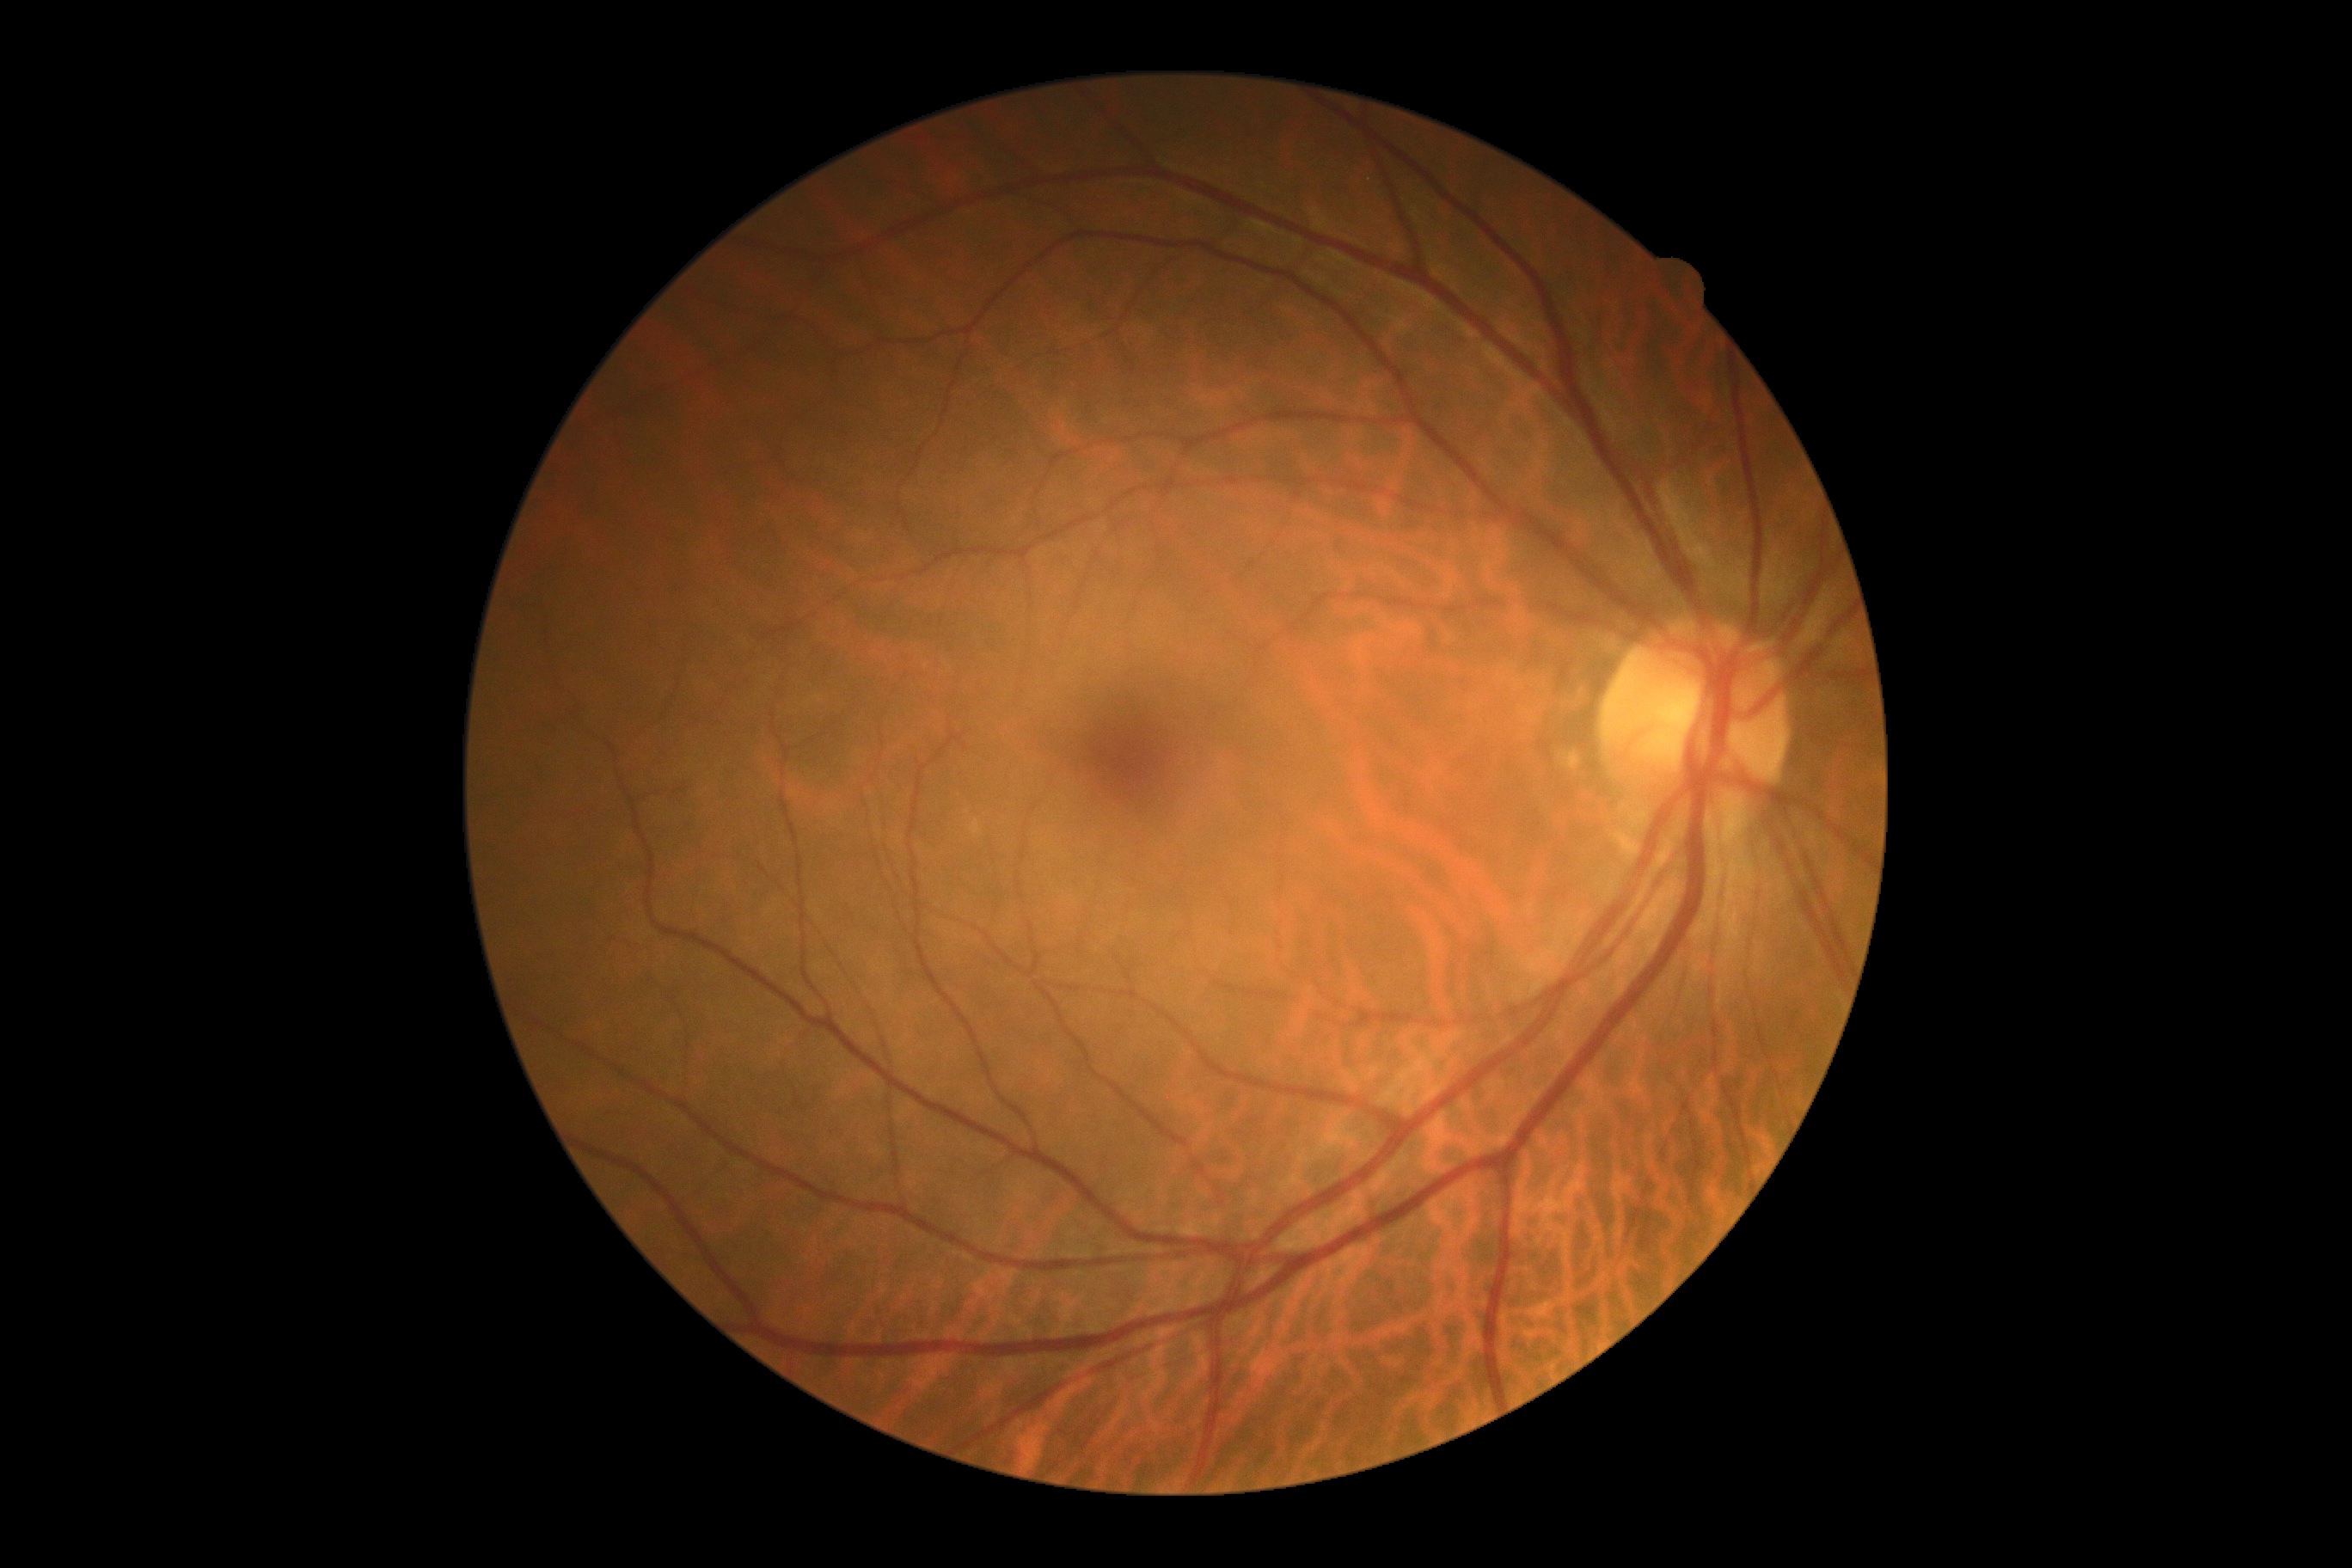 No diabetic retinal disease findings.
Diabetic retinopathy (DR): 0/4 — no visible signs of diabetic retinopathy.